Fundus photo. 2212x1659. 45-degree field of view
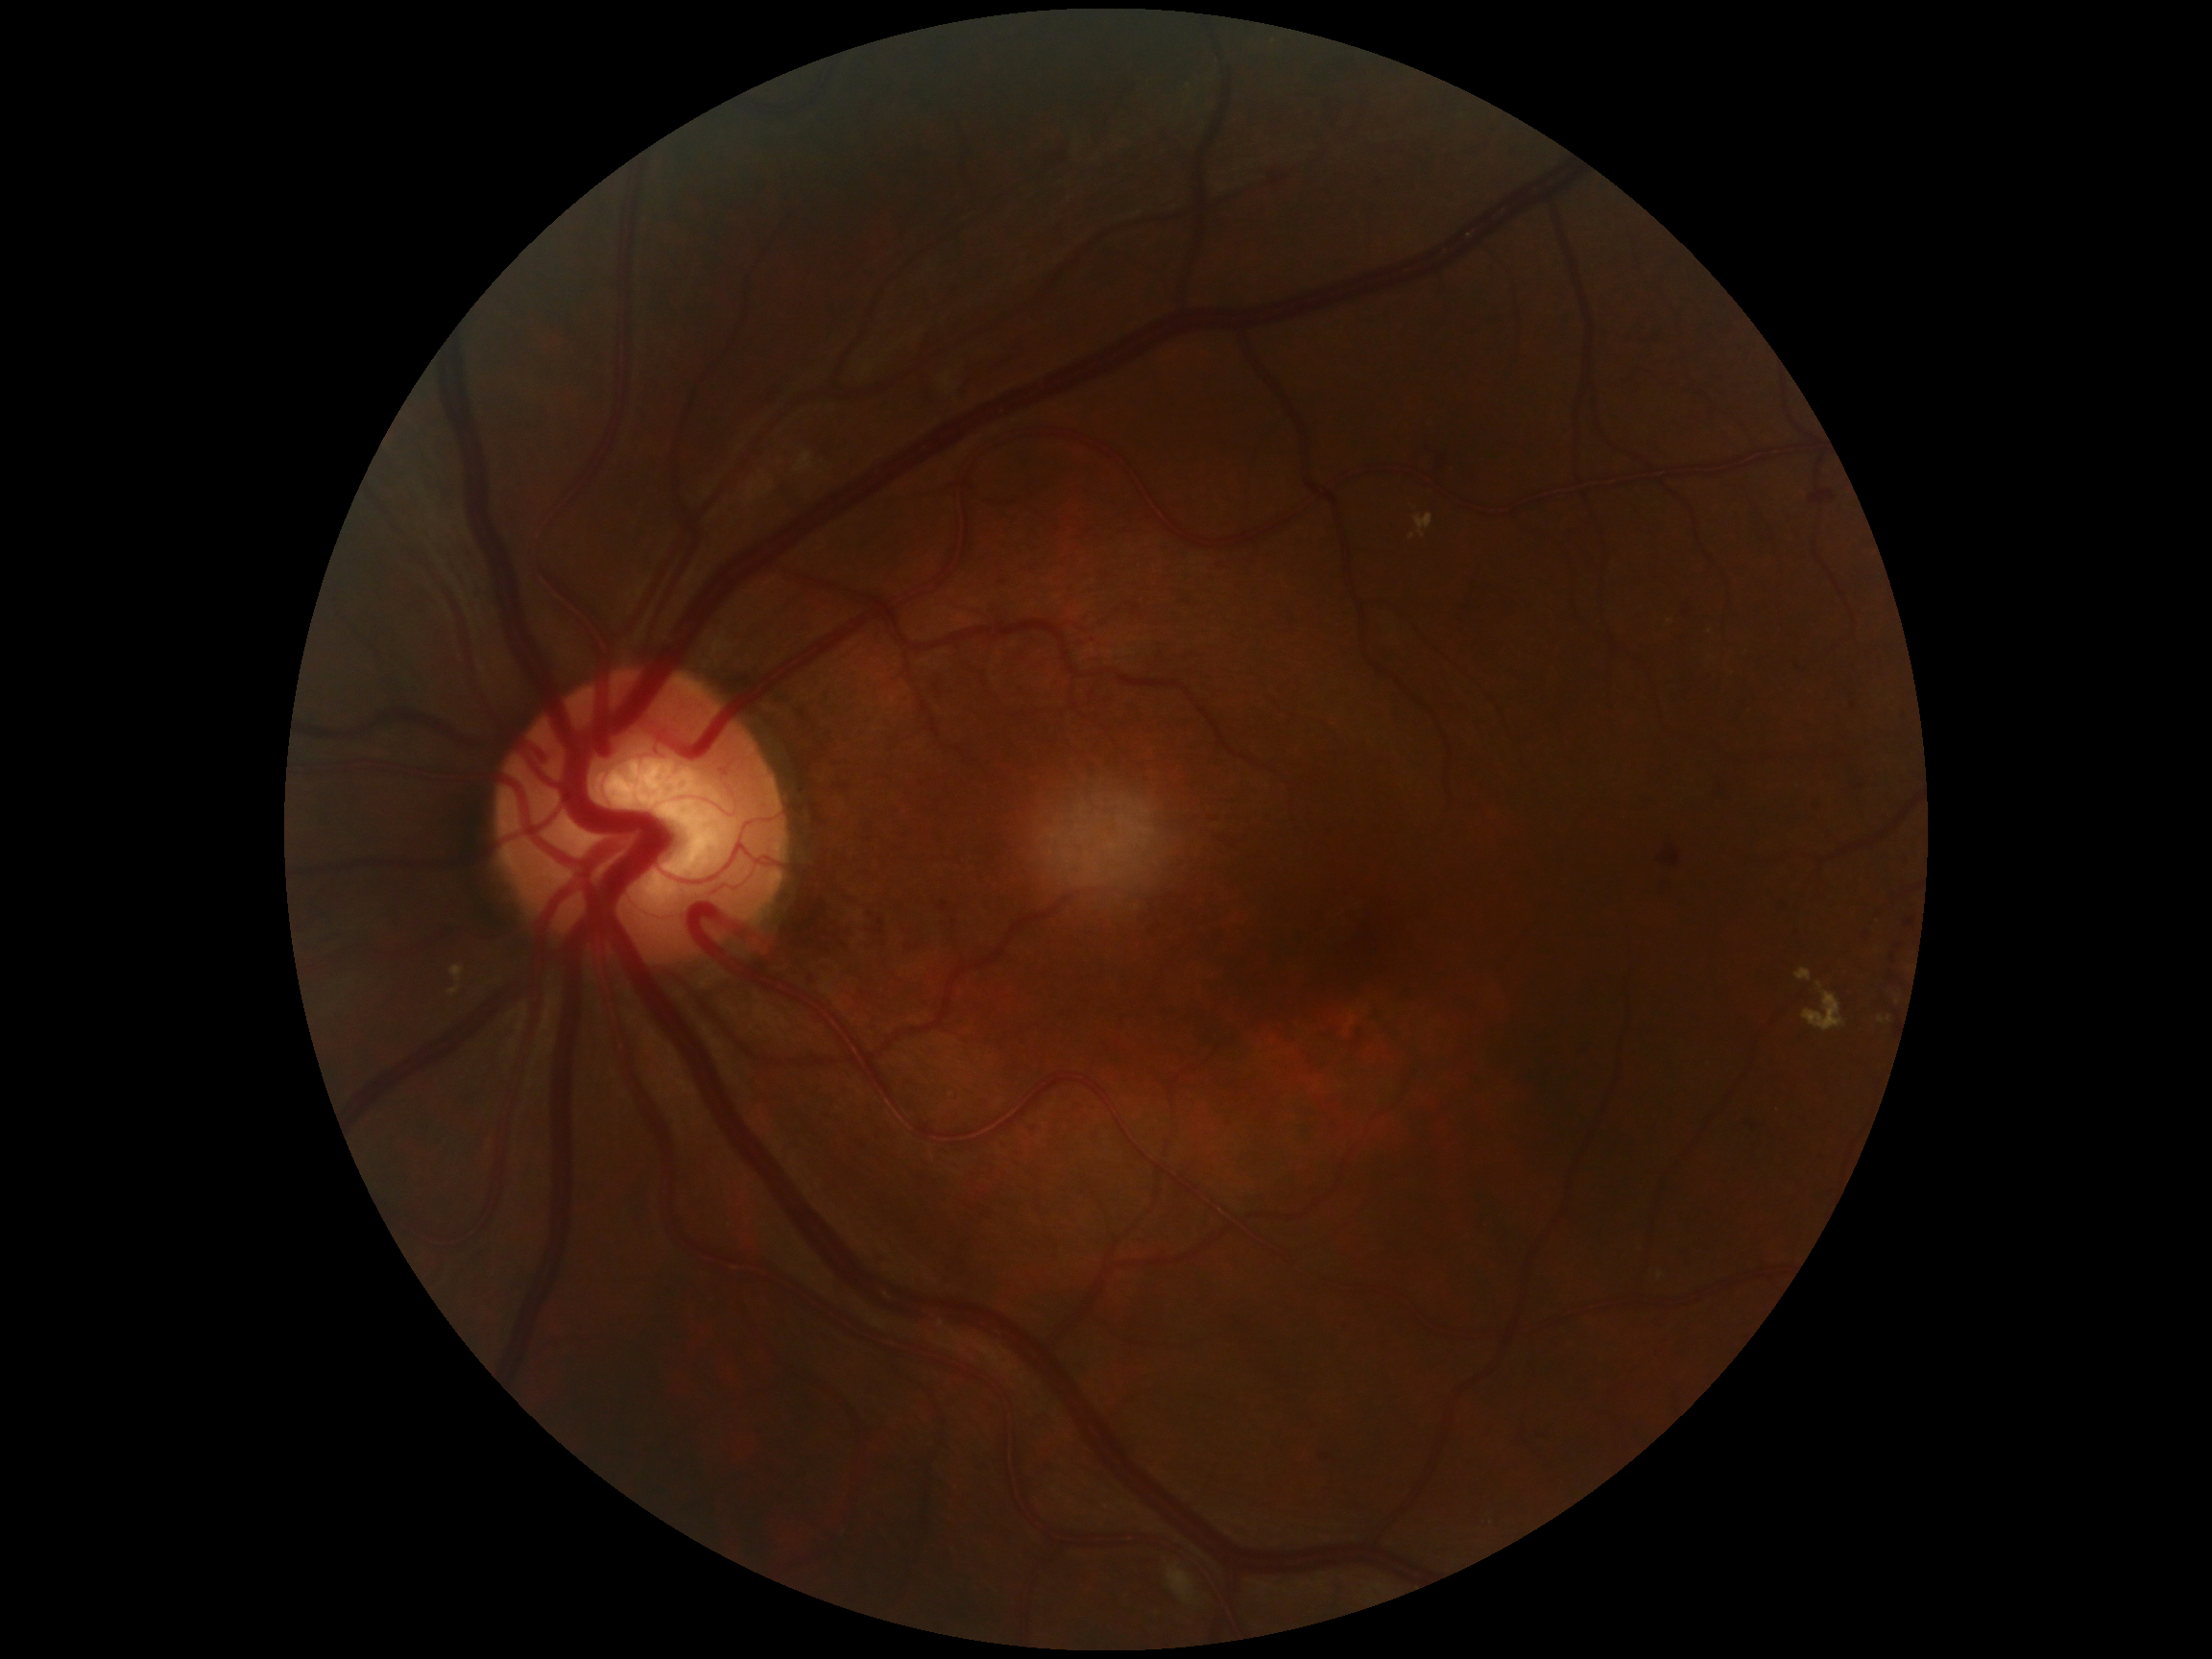

{"dr_grade": "grade 2 (moderate NPDR) — more than just microaneurysms but less than severe NPDR"}